Retinal fundus photograph. 2048 by 1536 pixels. 45° FOV — 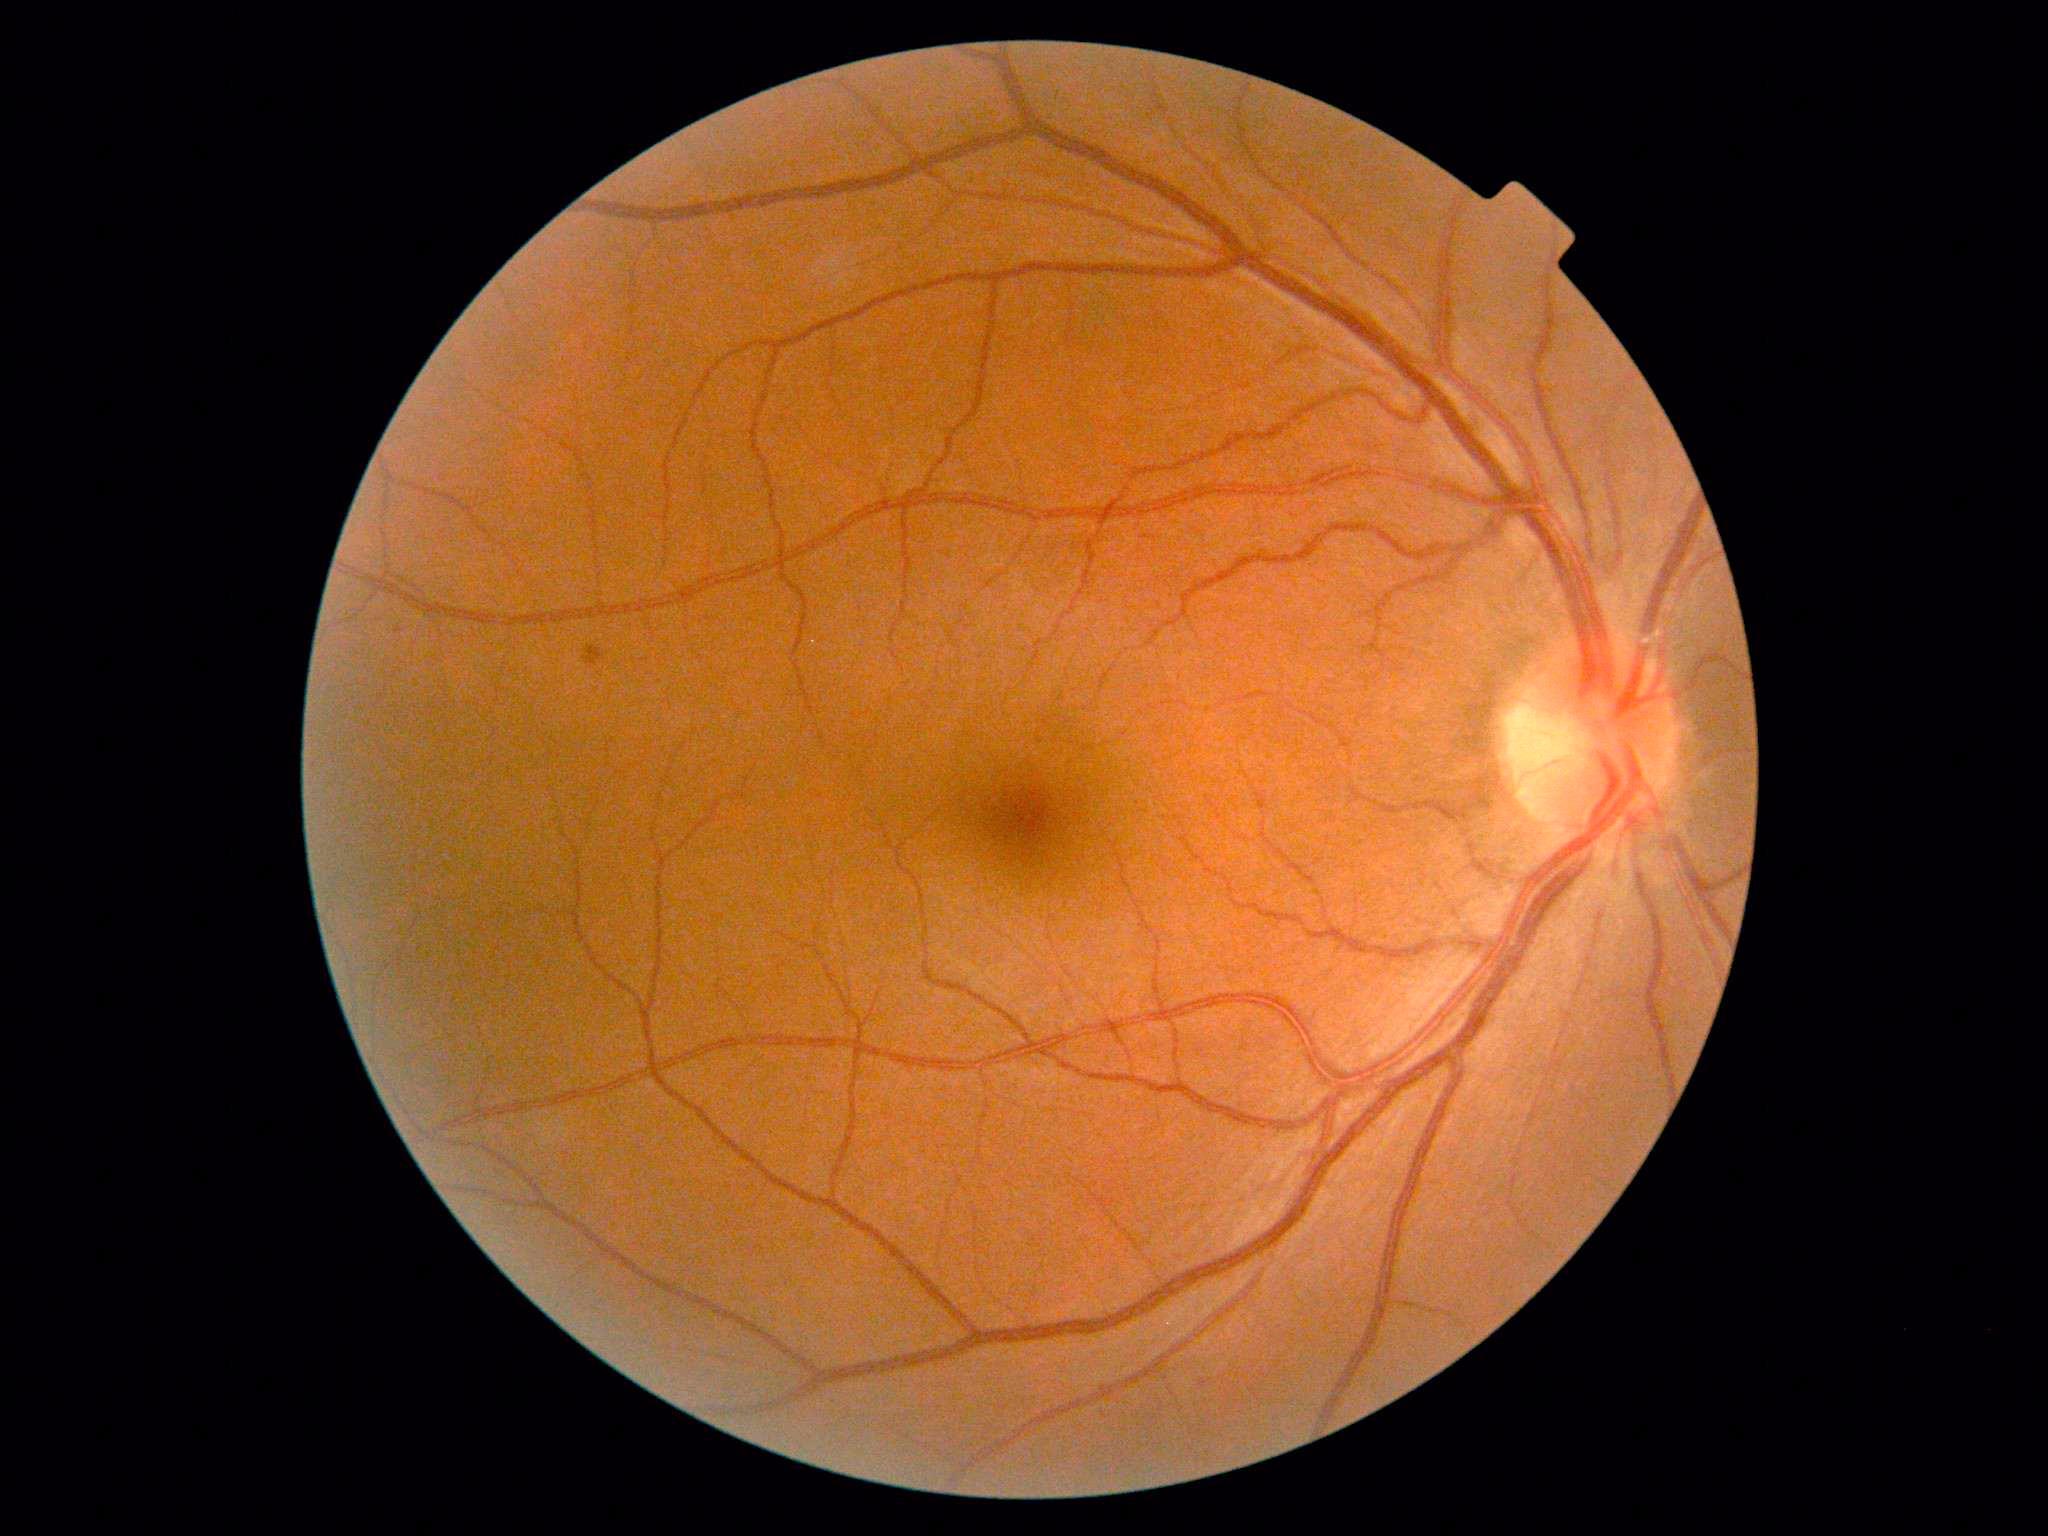 DR: mild NPDR (grade 1).